240x240px. Non-mydriatic. Cropped to the optic nerve head
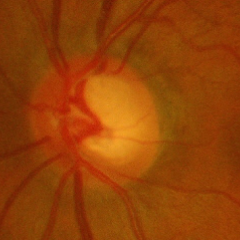
There is evidence of advanced glaucomatous optic neuropathy.